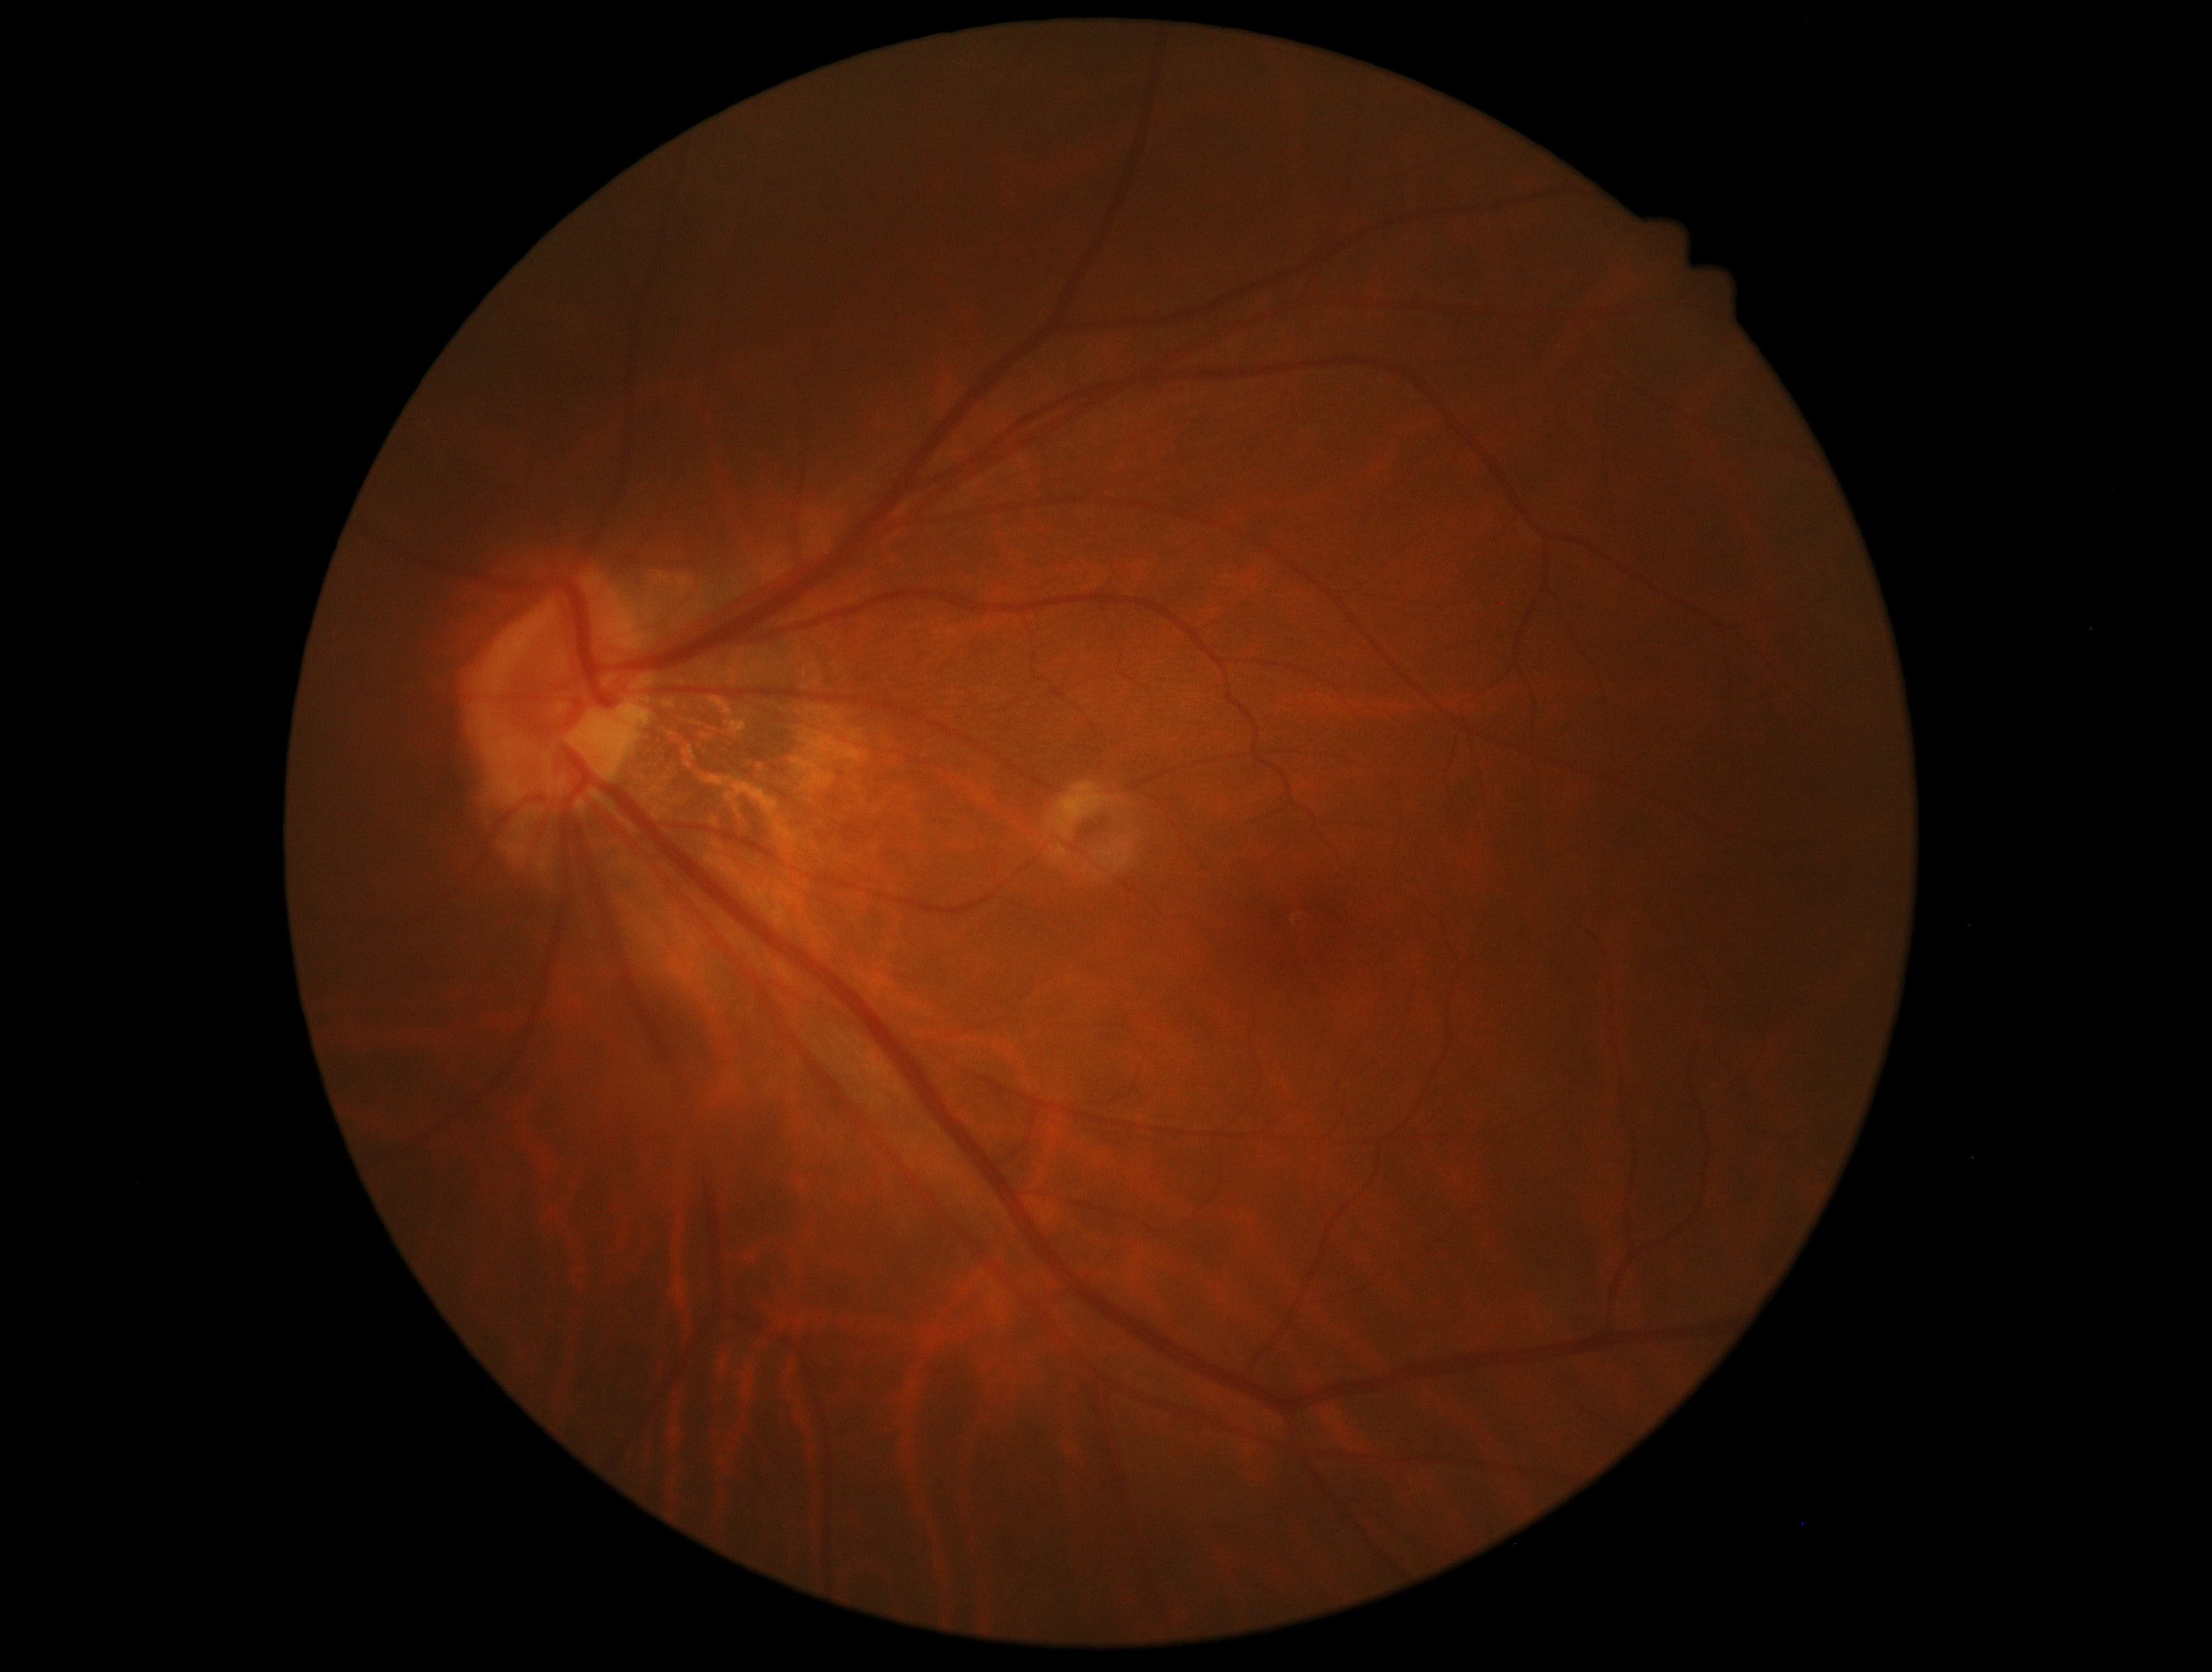

Diabetic retinopathy severity is no apparent retinopathy (grade 0).